No pharmacologic dilation:
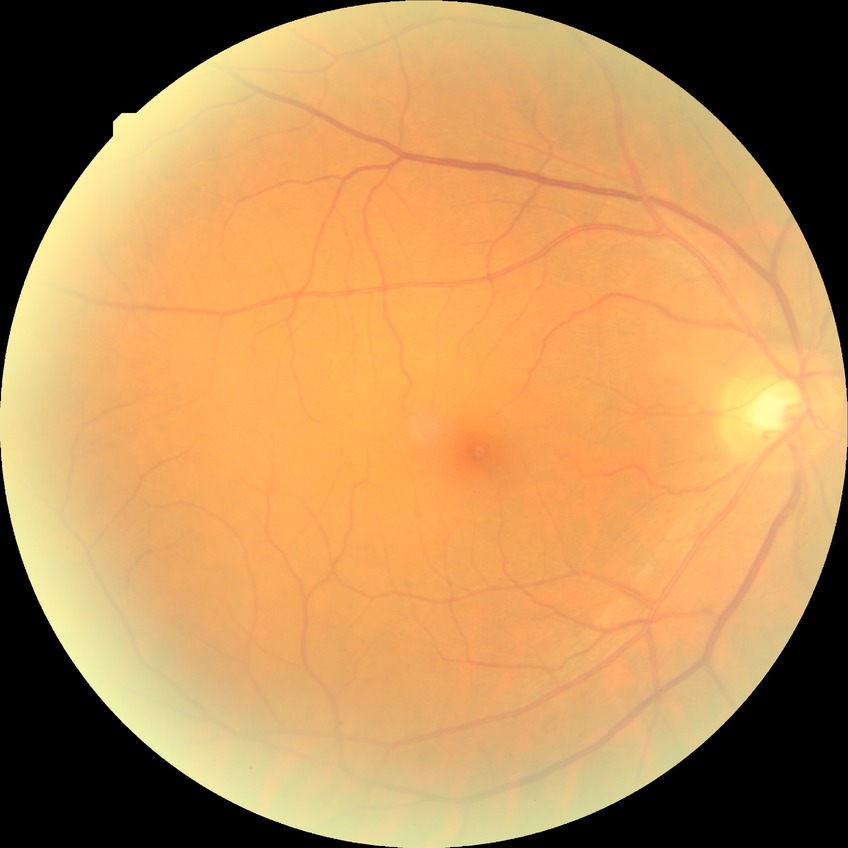 Davis stage: NDR.